848x848px. Nonmydriatic. Acquired with a NIDEK AFC-230. 45° FOV — 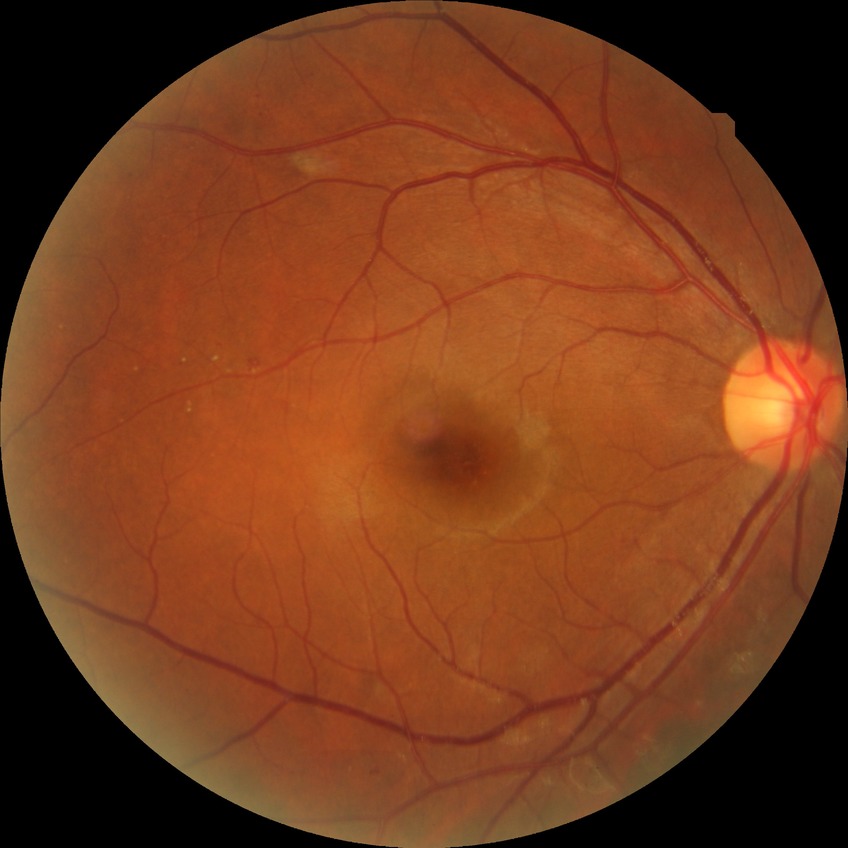

DR class: non-proliferative diabetic retinopathy. Diabetic retinopathy (DR): SDR (simple diabetic retinopathy).